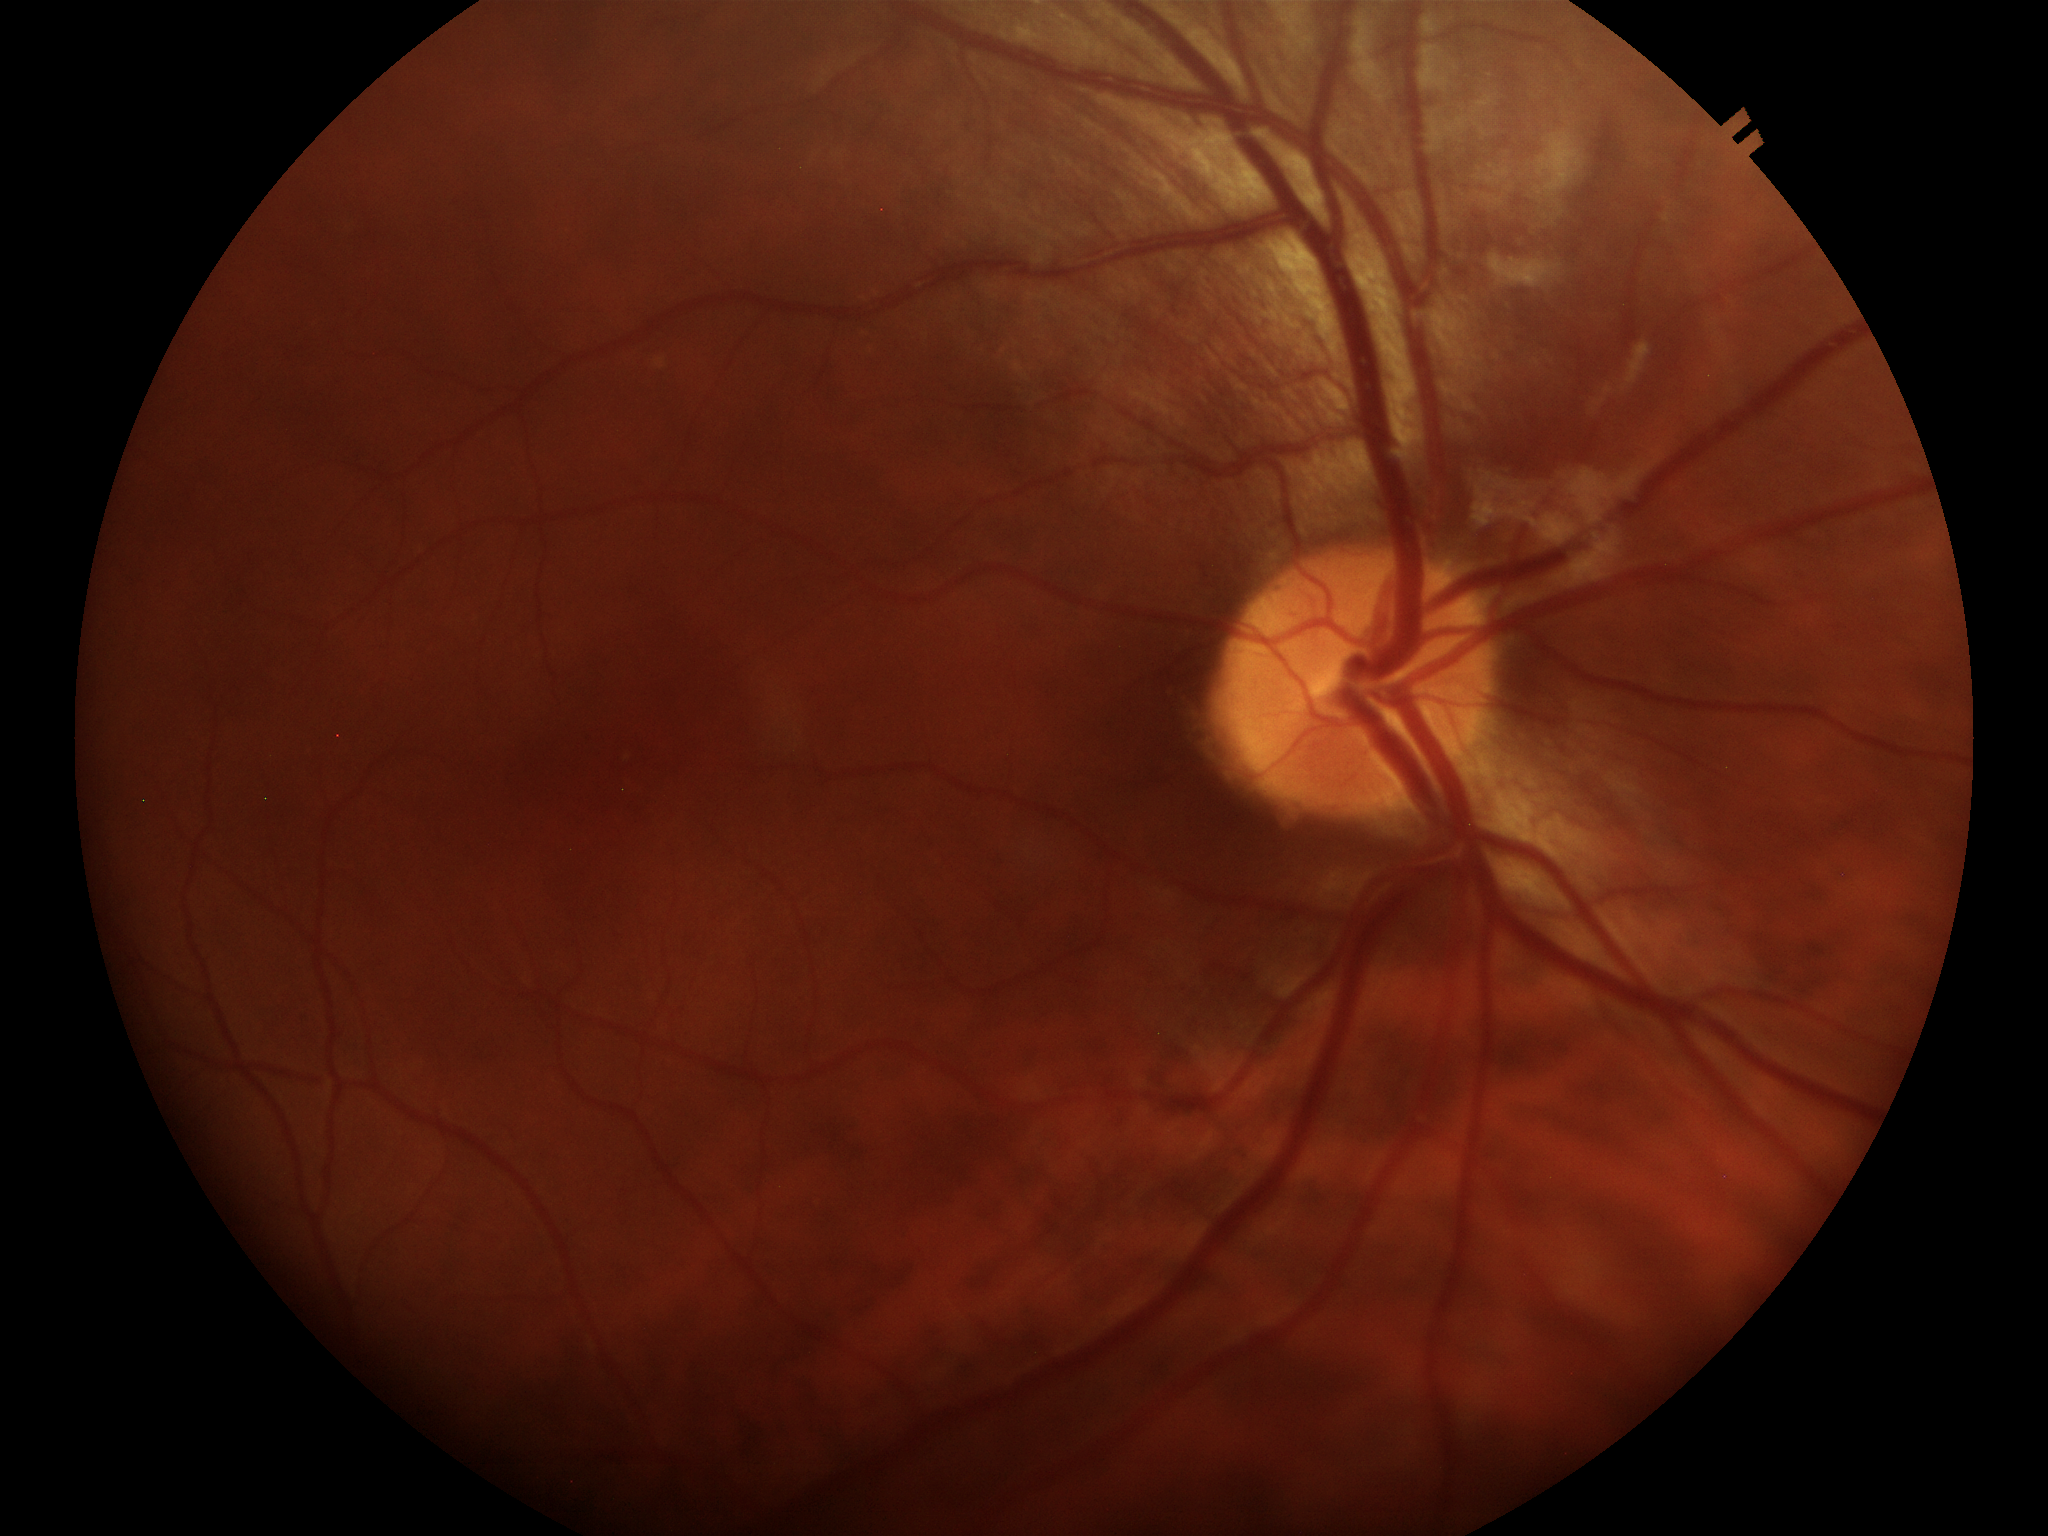 {"glaucoma_decision": "negative", "hcdr": "0.41", "vcdr": "0.44"}